Acquired with a NIDEK AFC-230; retinal fundus photograph; graded on the modified Davis scale: 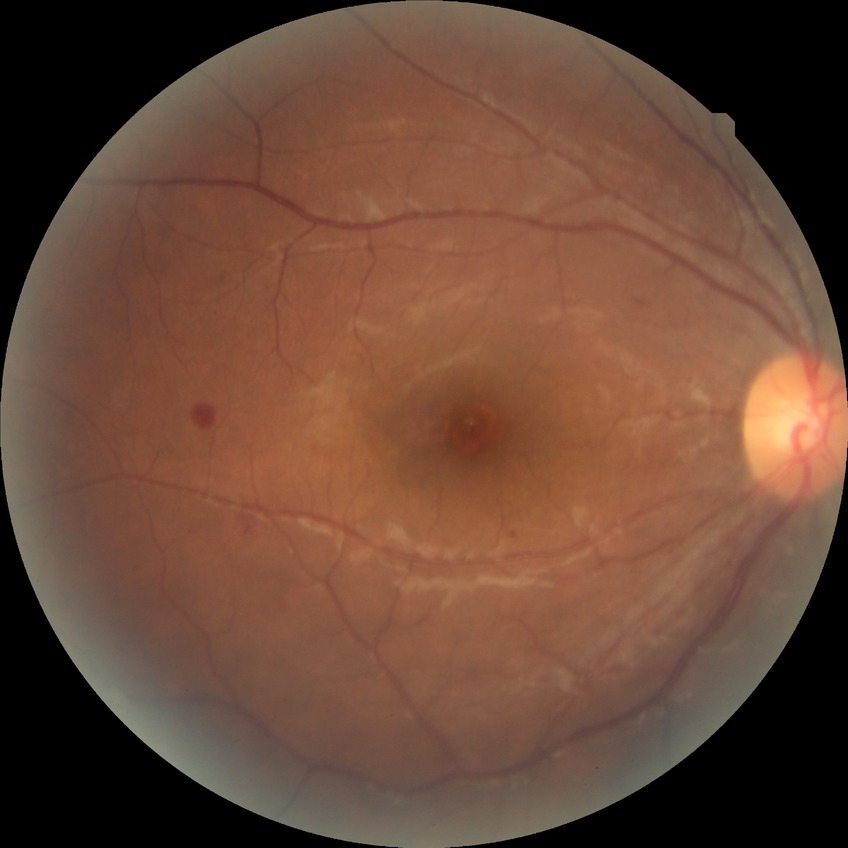

Diabetic retinopathy (DR) is NDR (no diabetic retinopathy).